640 by 480 pixels · camera: Clarity RetCam 3 (130° FOV) · wide-field fundus photograph of an infant — 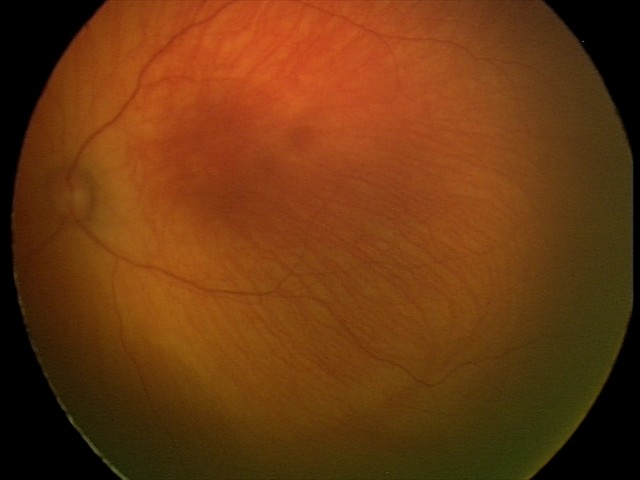

Examination with physiological retinal findings.